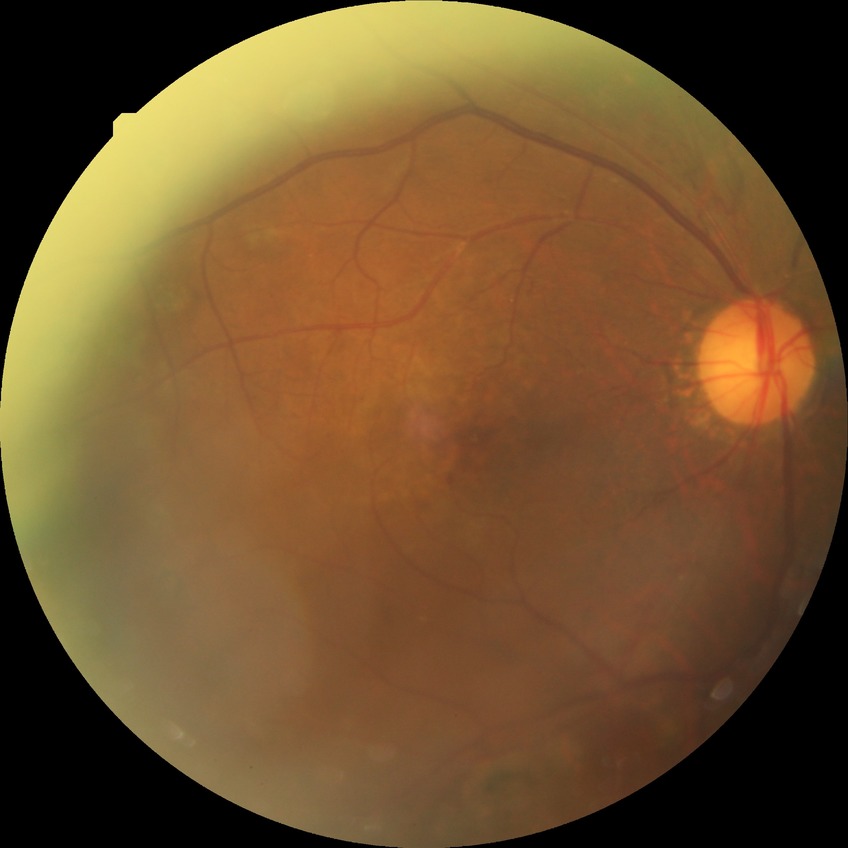

{
  "davis_grade": "PDR (proliferative diabetic retinopathy)"
}